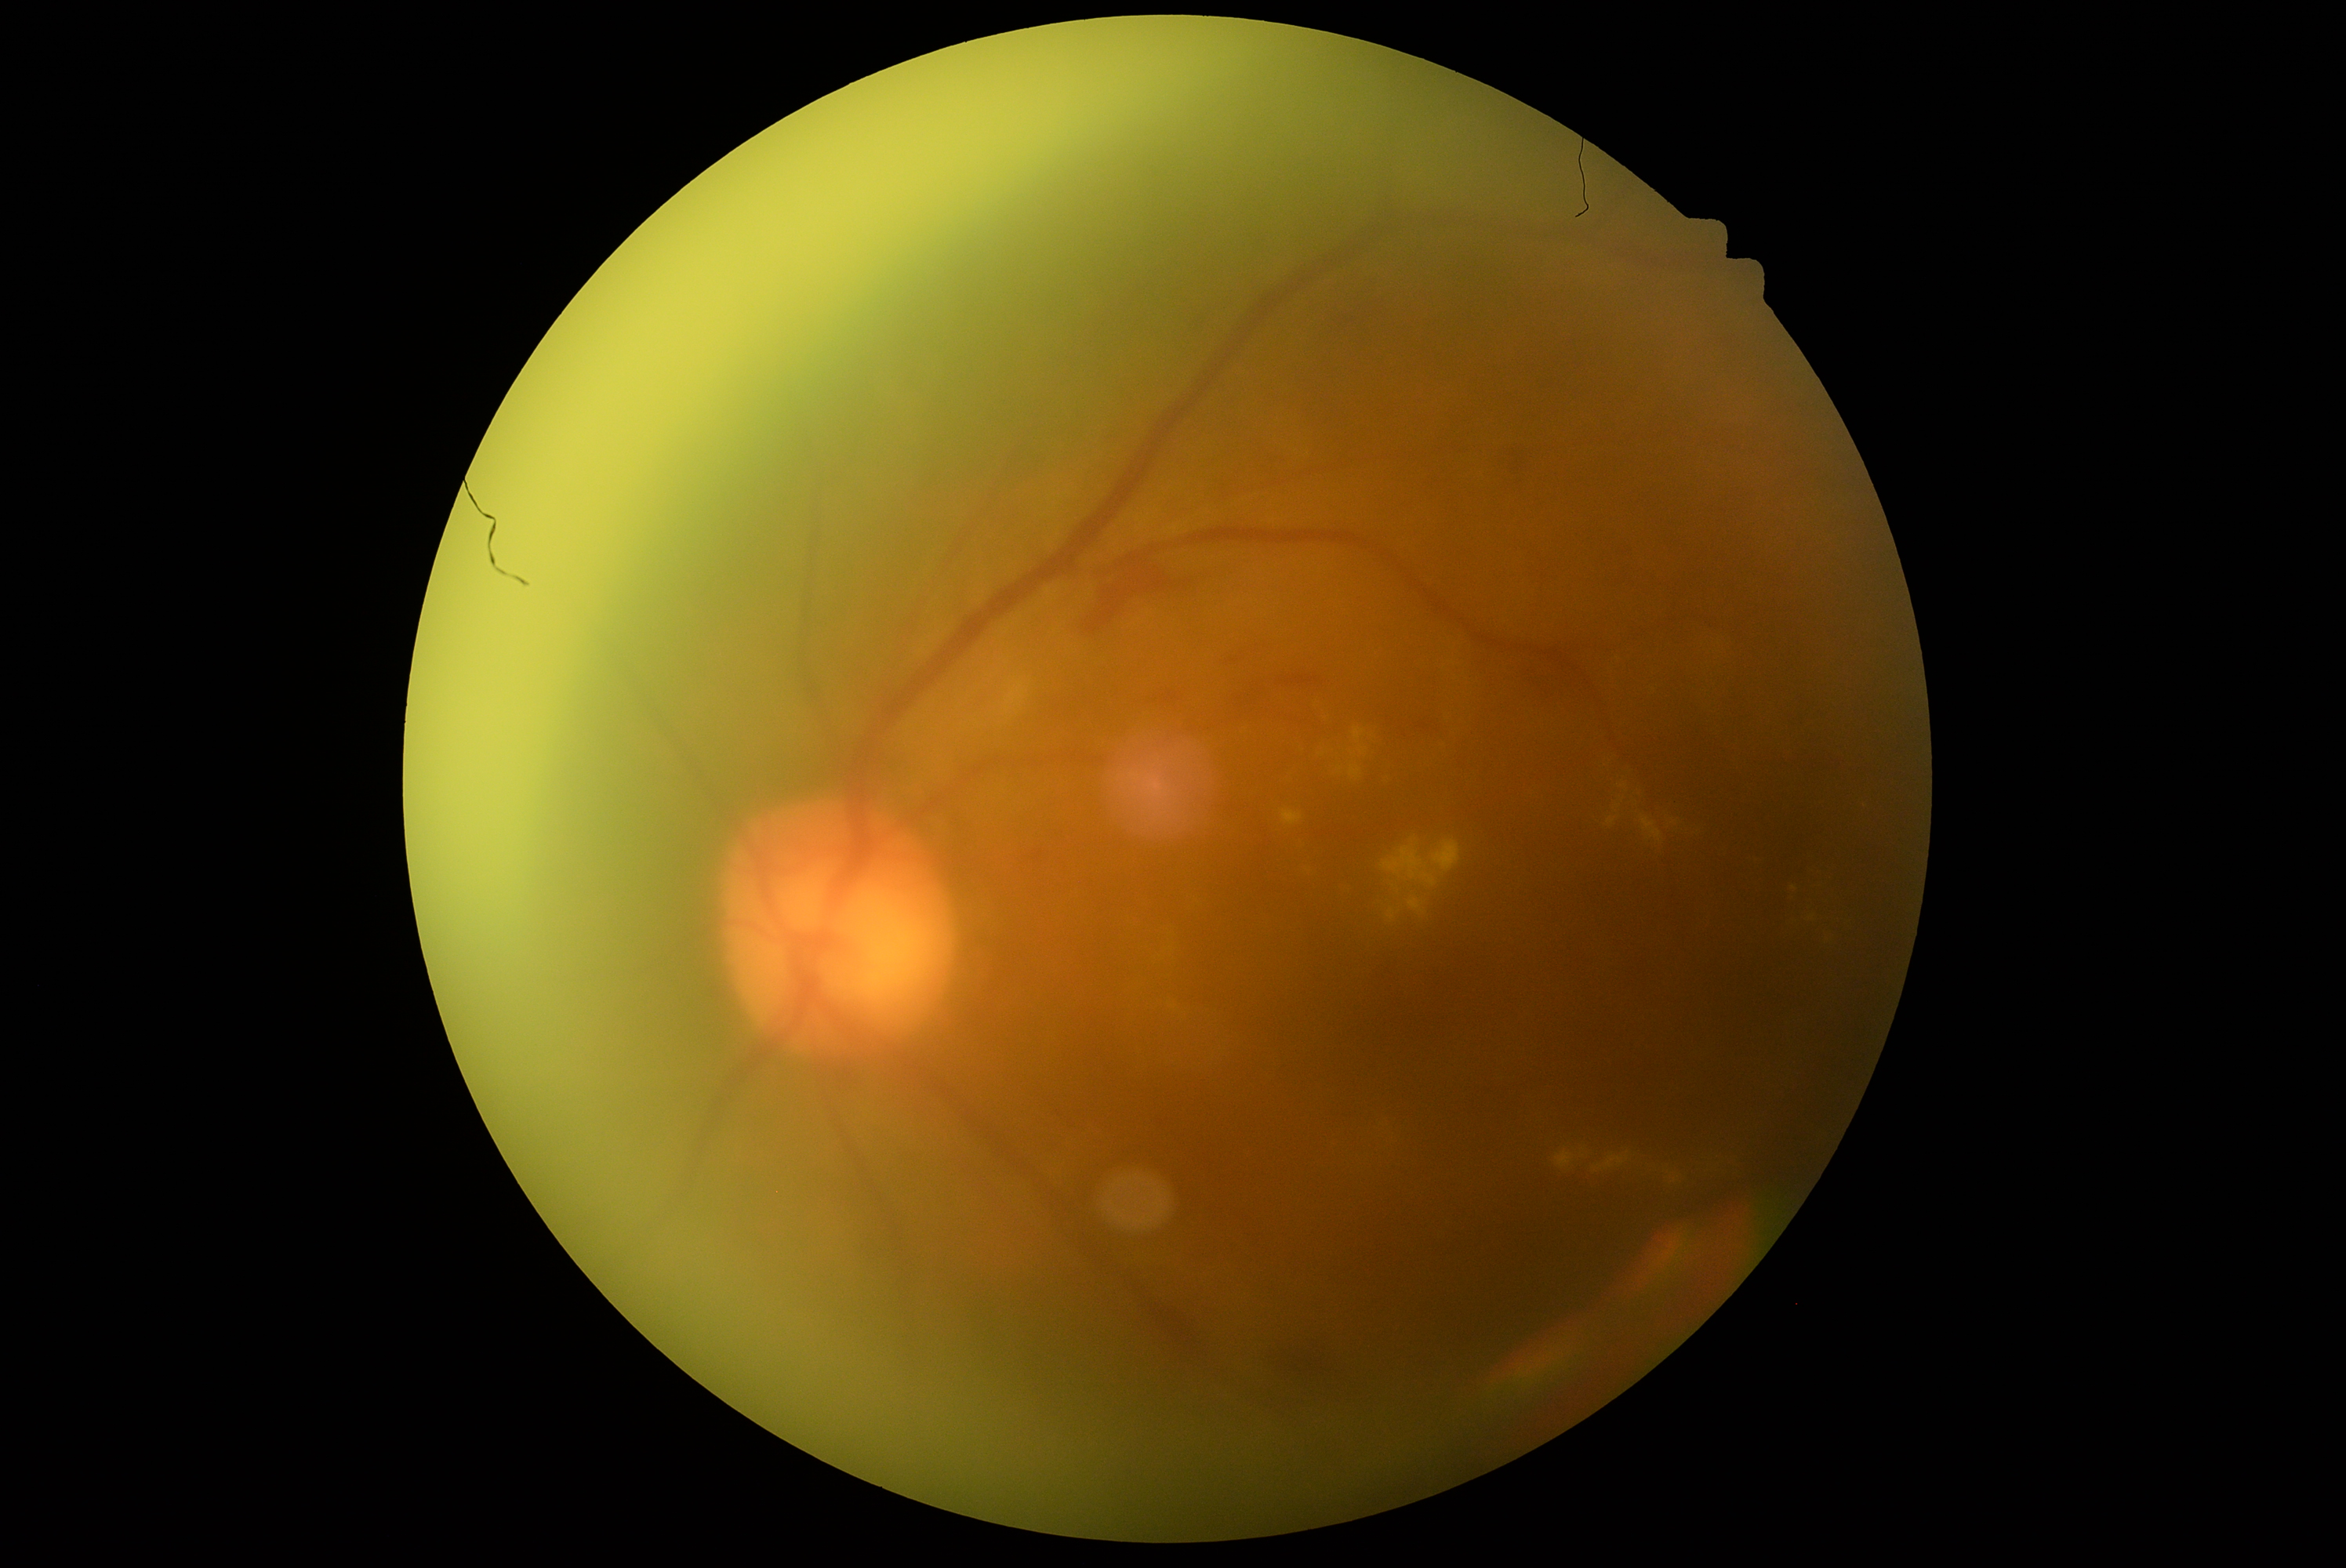

Diabetic retinopathy (DR) is grade 2 (moderate NPDR).